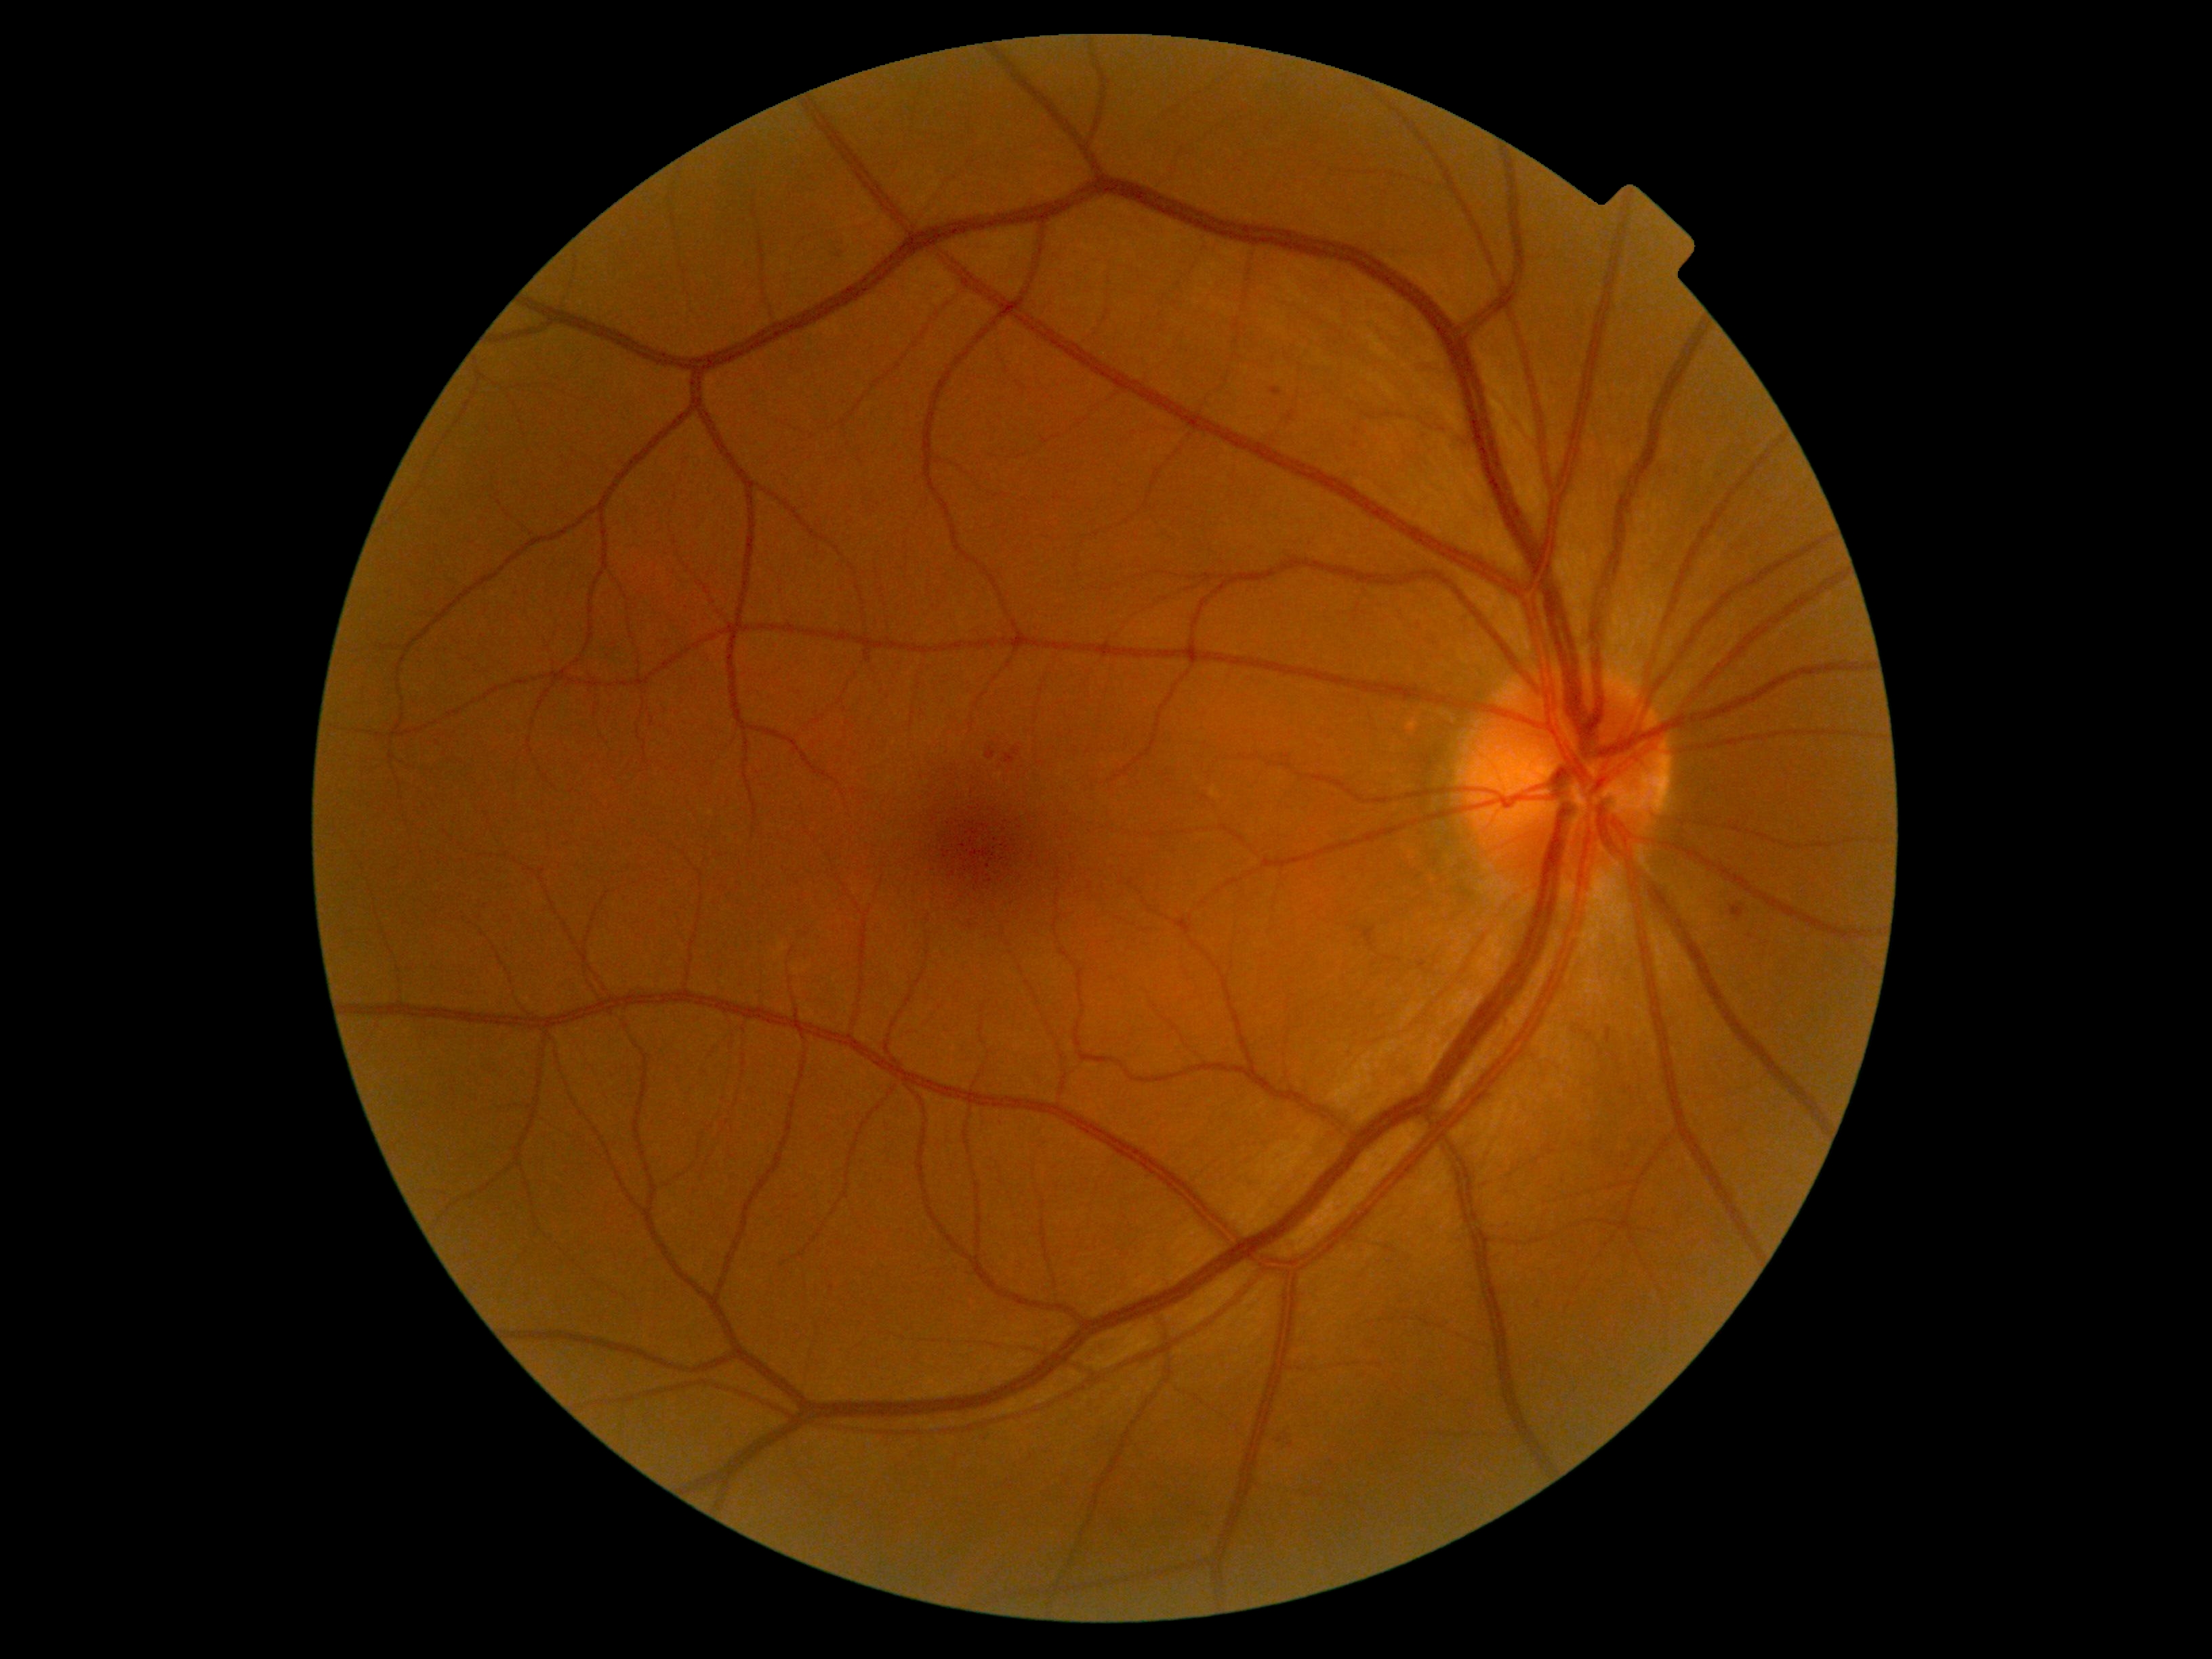 diabetic retinopathy (DR) = 2.